640 x 480 pixels; captured with the Clarity RetCam 3 (130° field of view); pediatric wide-field fundus photograph:
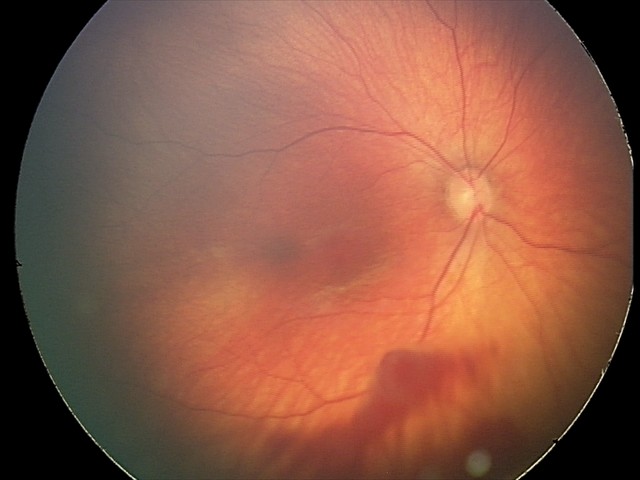
Examination diagnosed as retinal hemorrhages.